Acquired with a NIDEK AFC-230; posterior pole color fundus photograph — 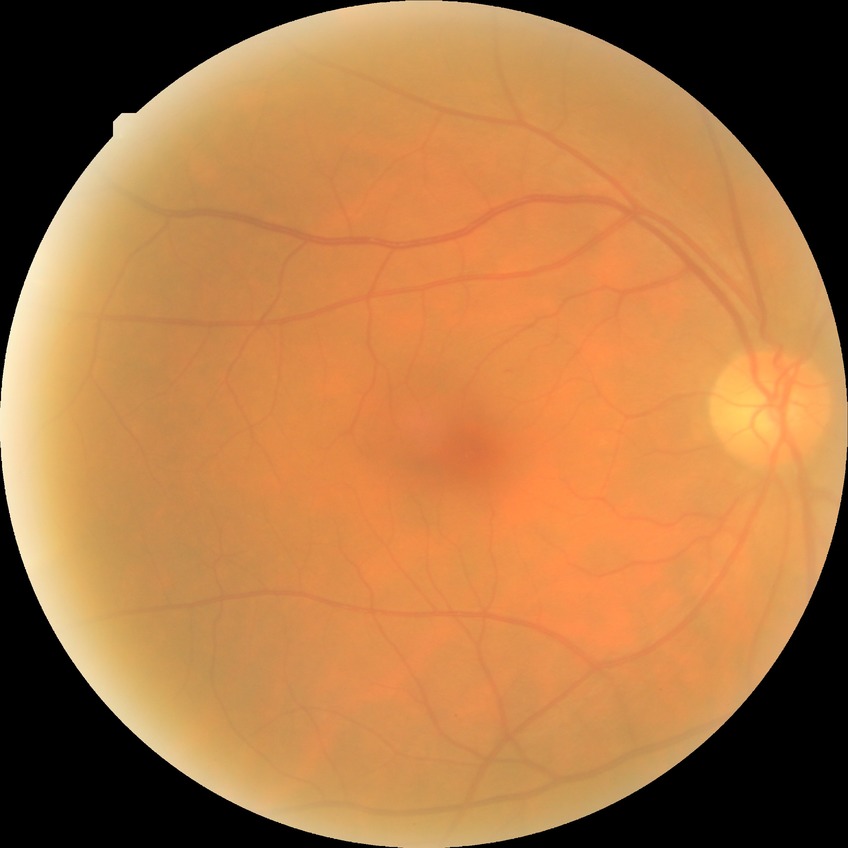 – DR severity: NDR
– DR impression: negative for DR